45° FOV; 848 x 848 pixels
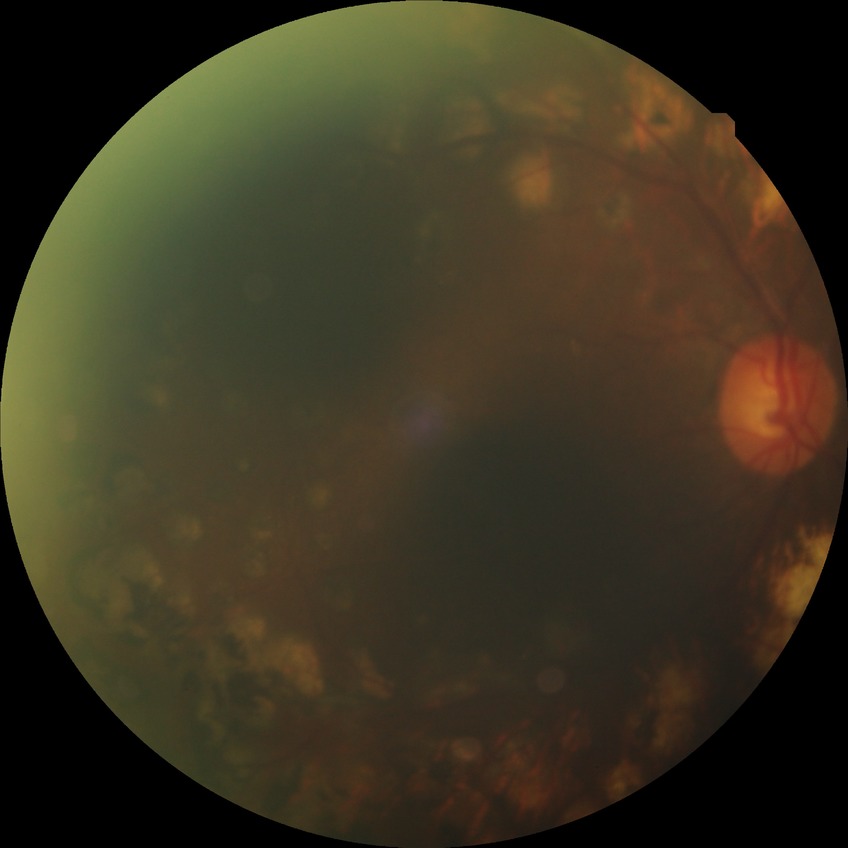

{
  "davis_grade": "PDR"
}